50° field of view, camera: Topcon TRC-50DX, central posterior field, retinal fundus photograph, image size 2228x1652, mydriatic (tropicamide and phenylephrine).
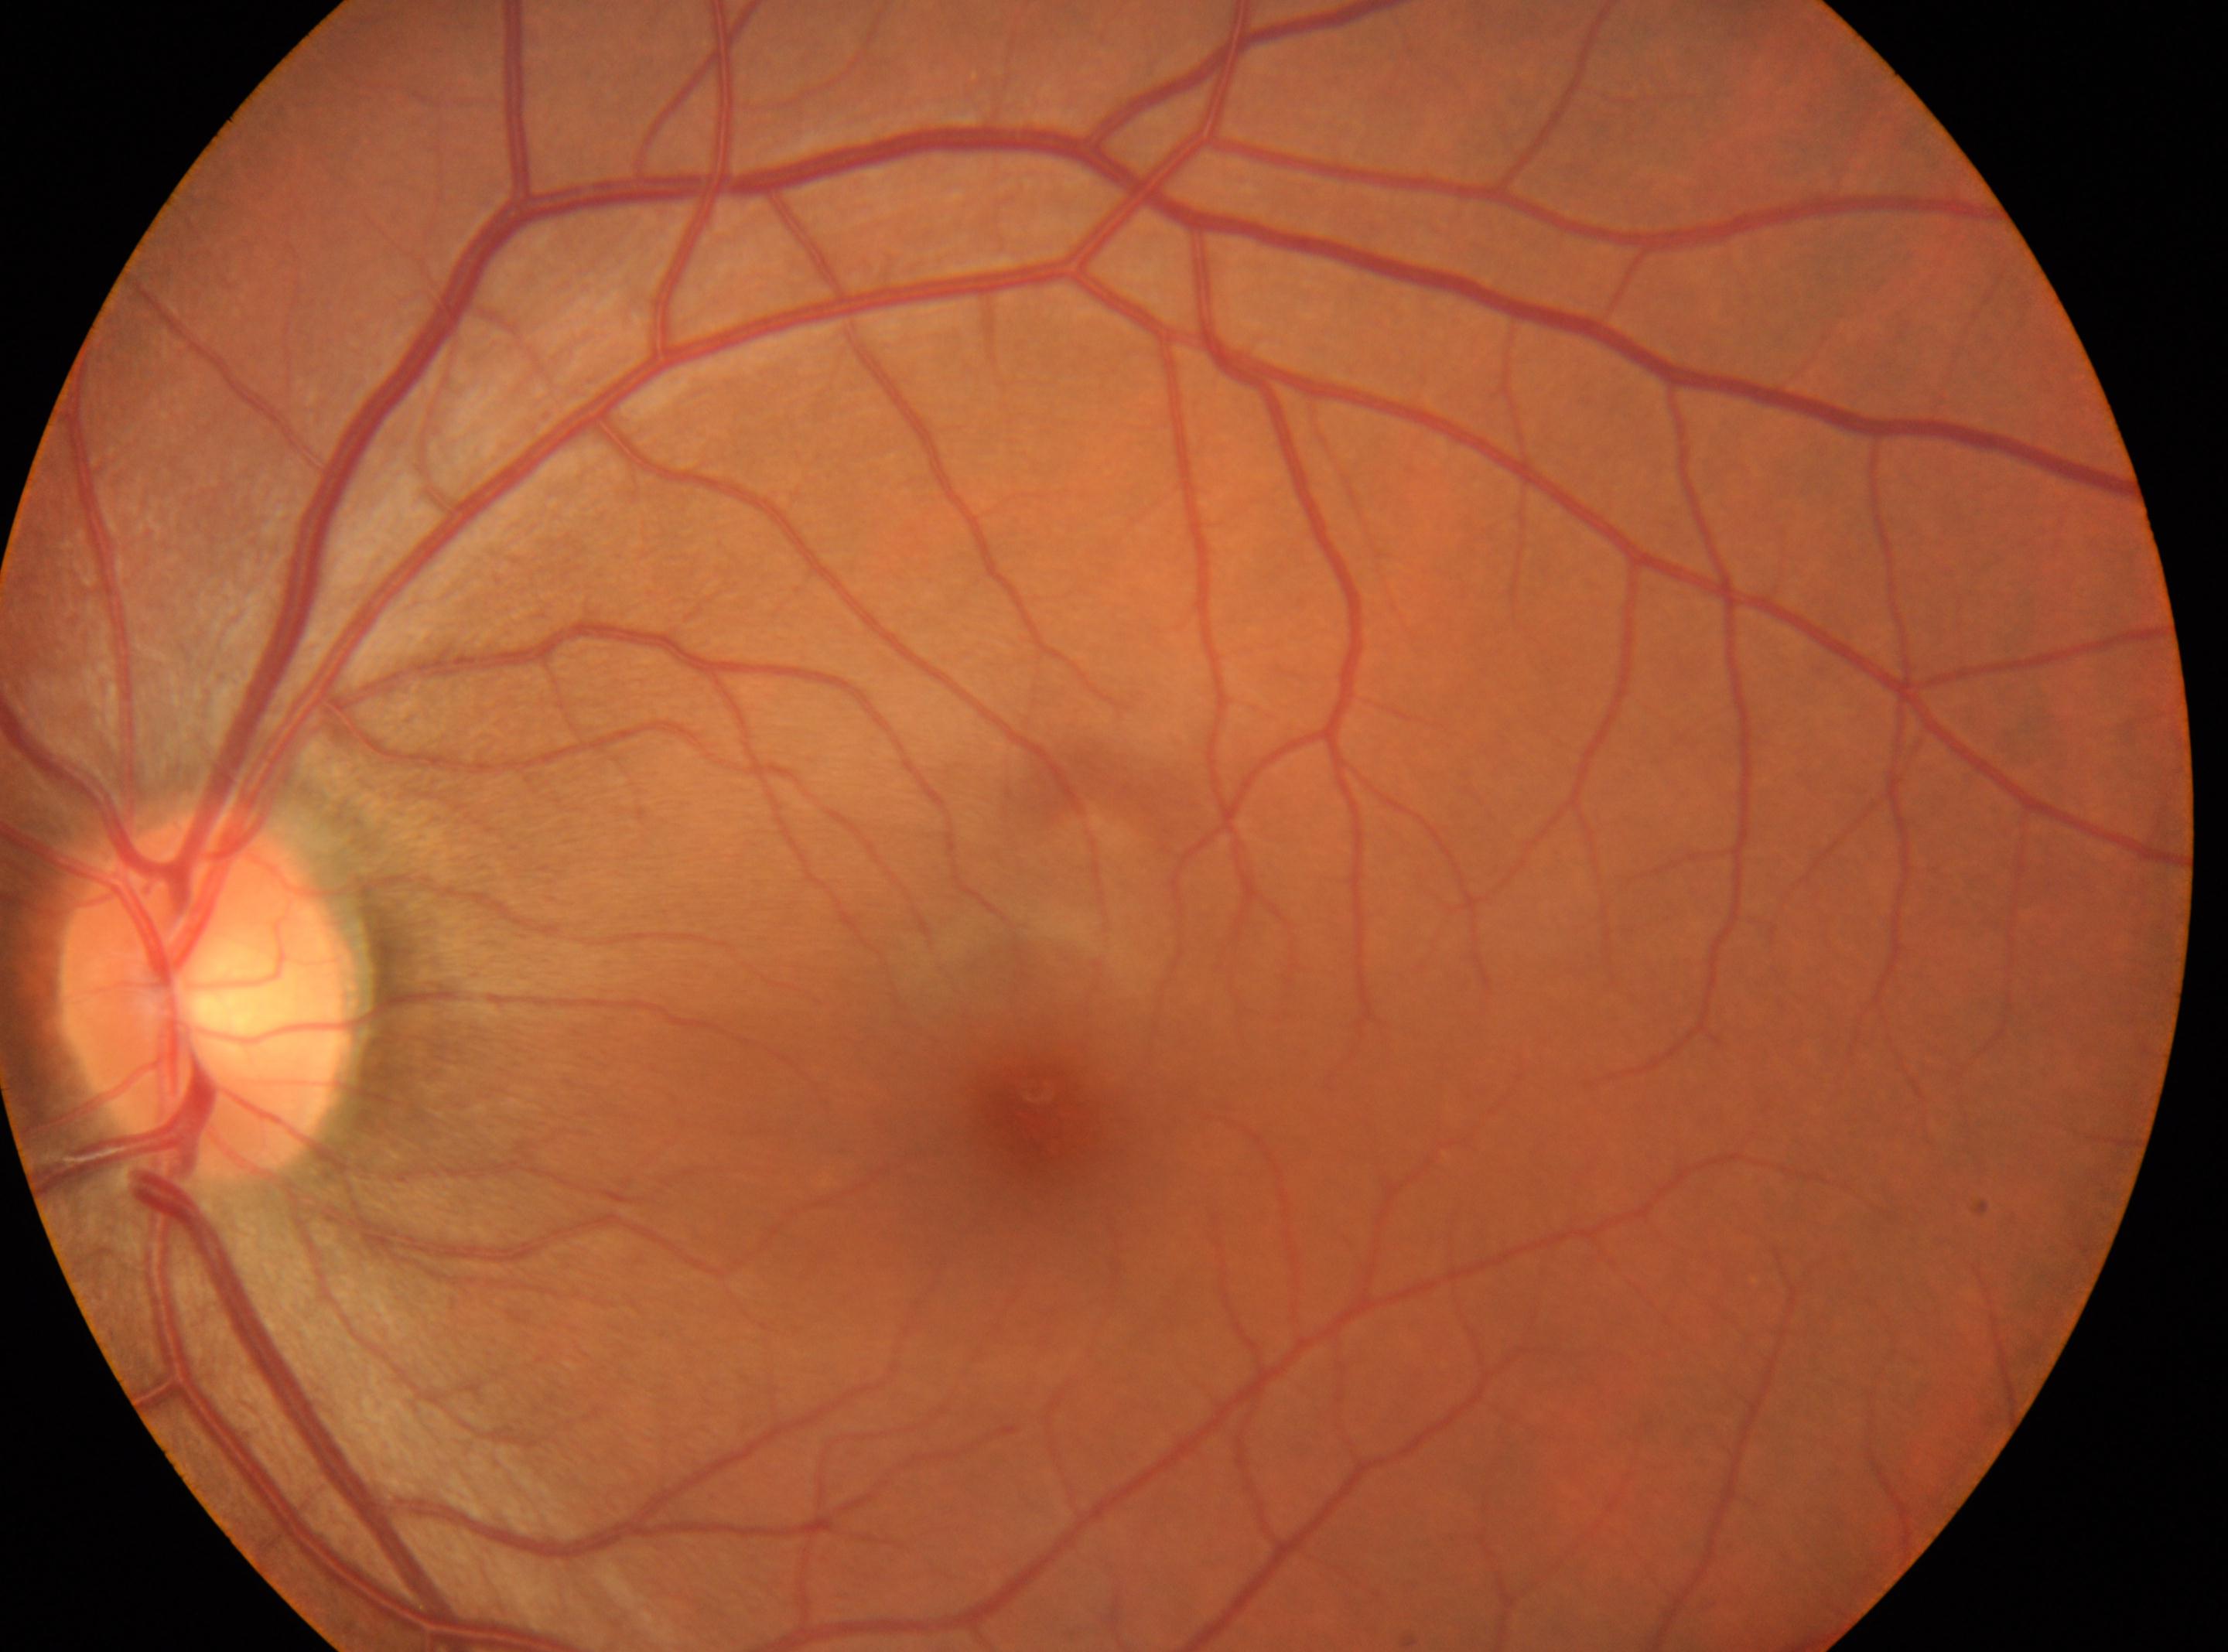

Foveal center located at (1035, 1129). Eye: left. Retinopathy grade is 0 (no apparent retinopathy). ONH: (206, 995).